Ultra-widefield fundus mosaic
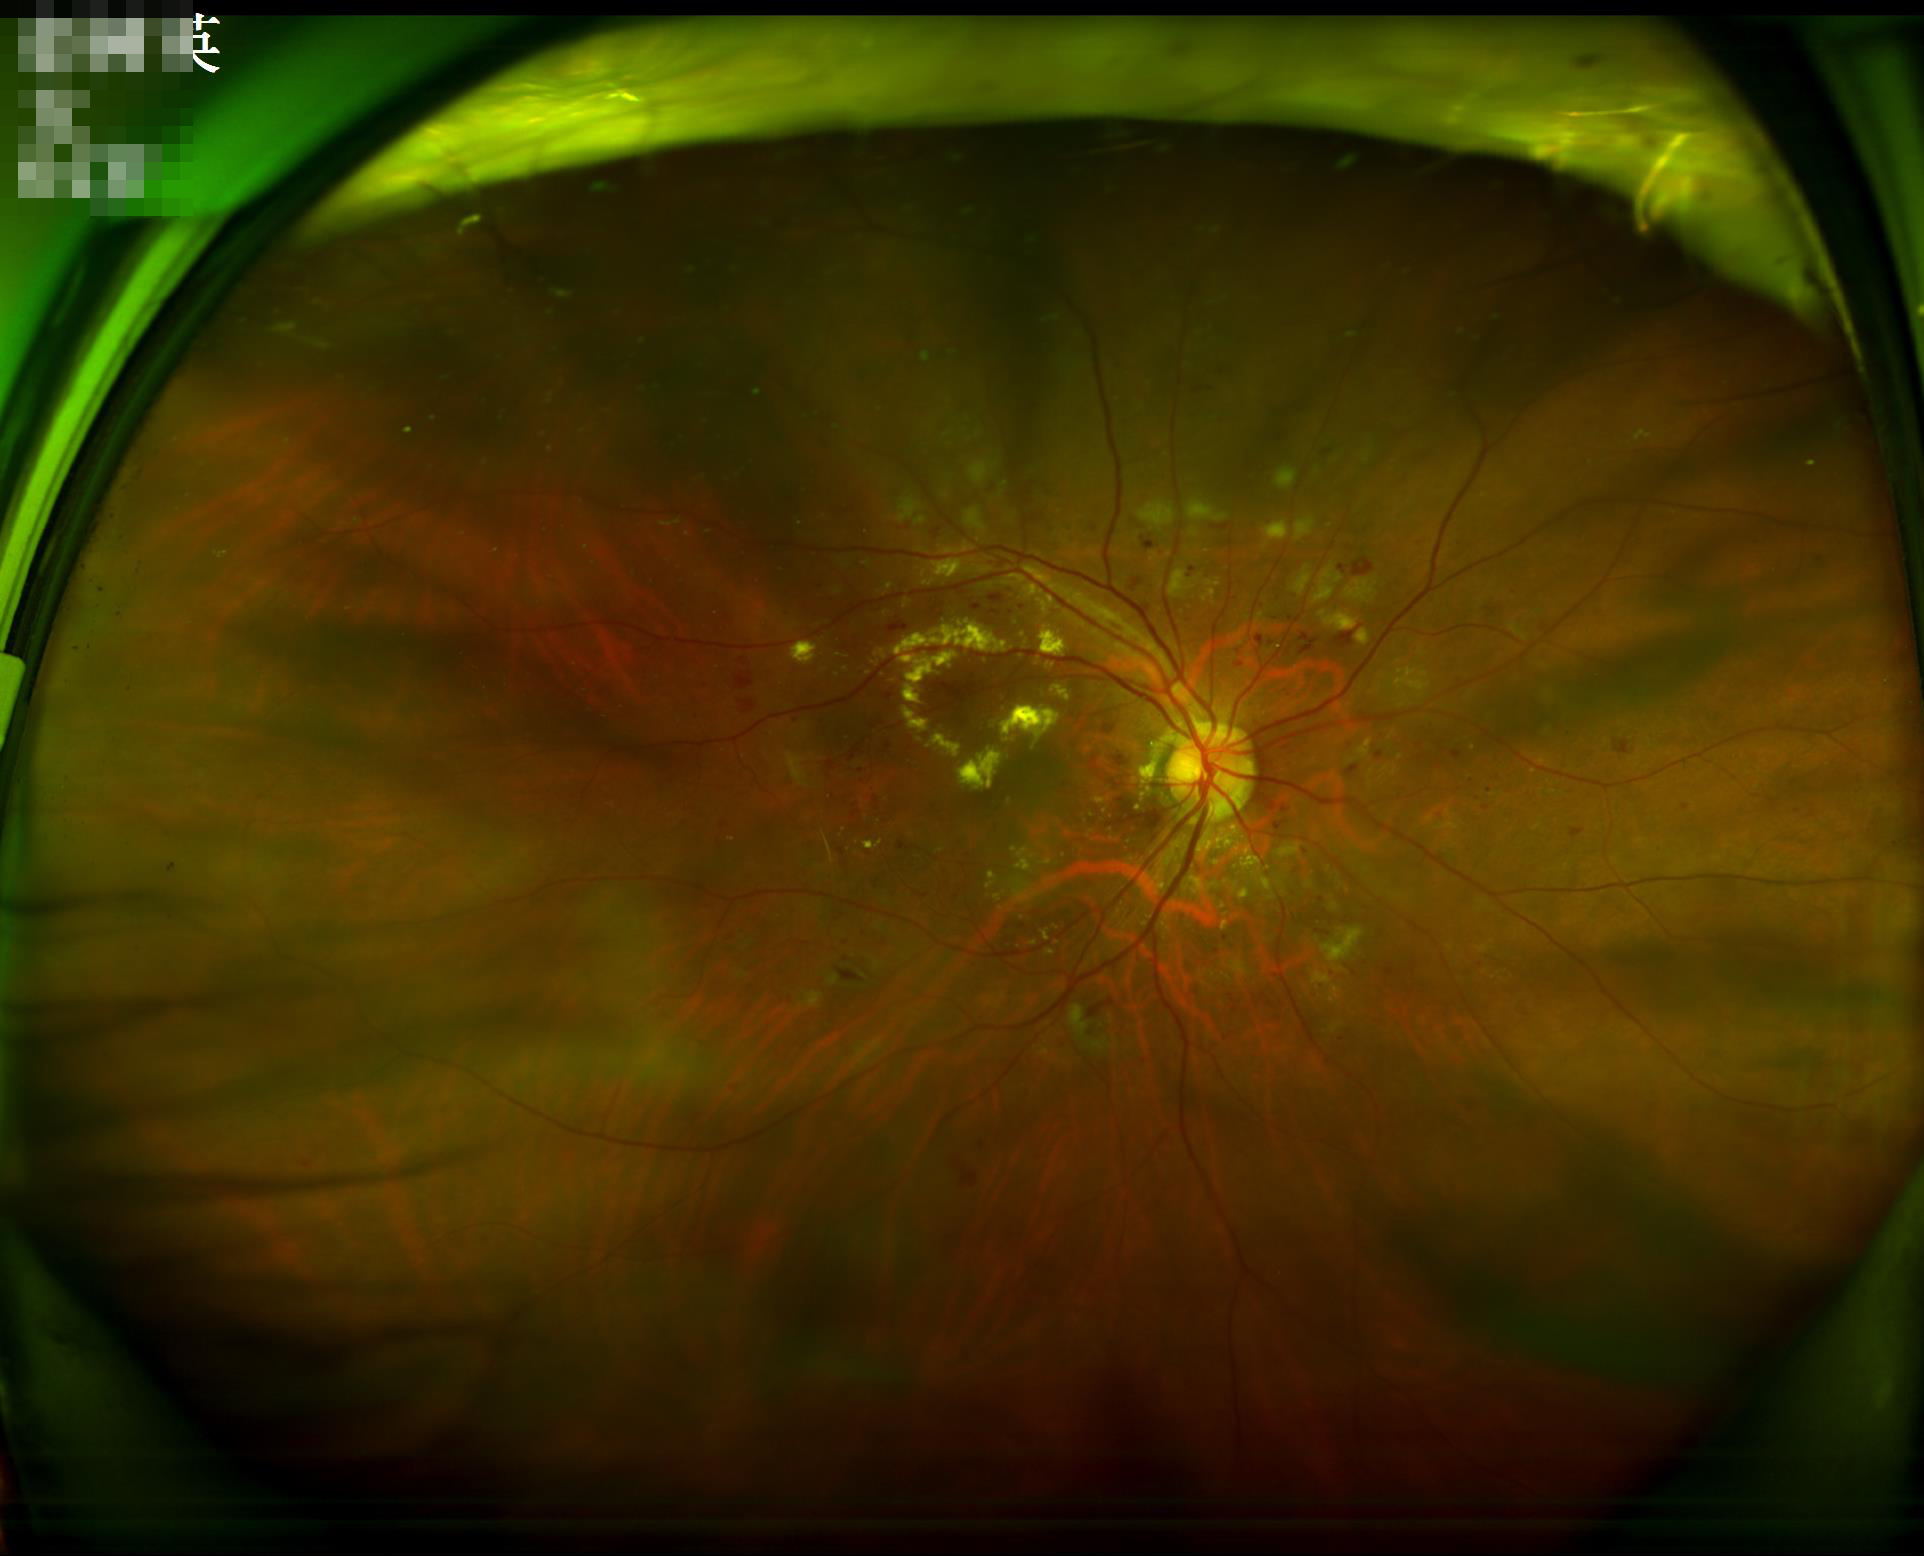
Quality grading: illumination/color: even | overall: satisfactory | contrast: satisfactory | focus: reduced.